640x480px. Clarity RetCam 3, 130° FOV. Infant wide-field fundus photograph
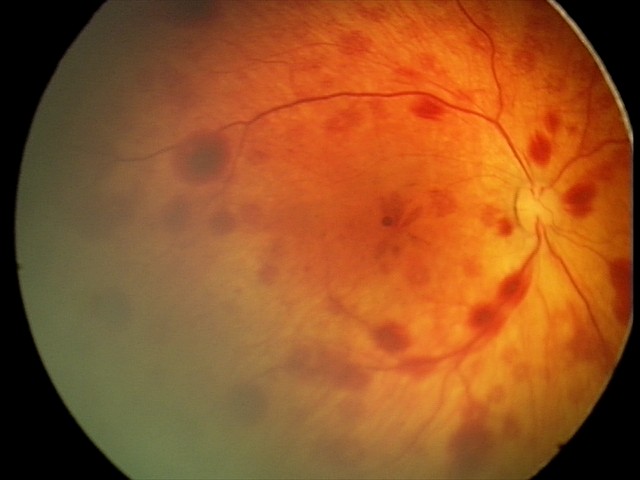 Diagnosis from this screening exam: retinal hemorrhages.